Color fundus image, NIDEK AFC-230, nonmydriatic fundus photograph, graded on the modified Davis scale, 848x848px.
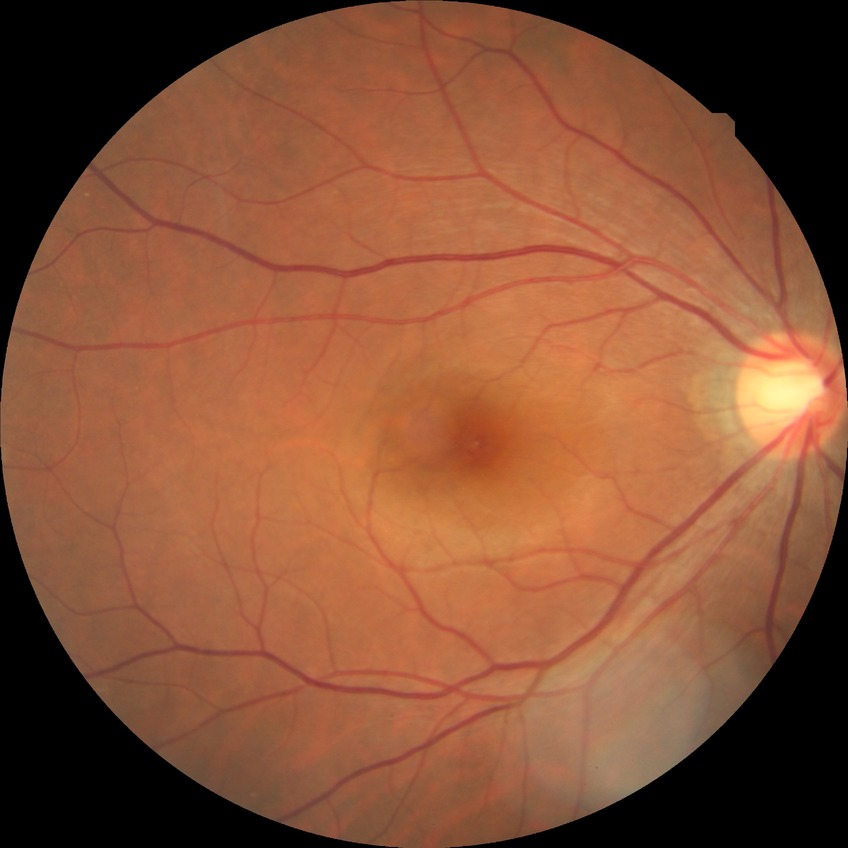
Diabetic retinopathy (DR): no diabetic retinopathy (NDR).